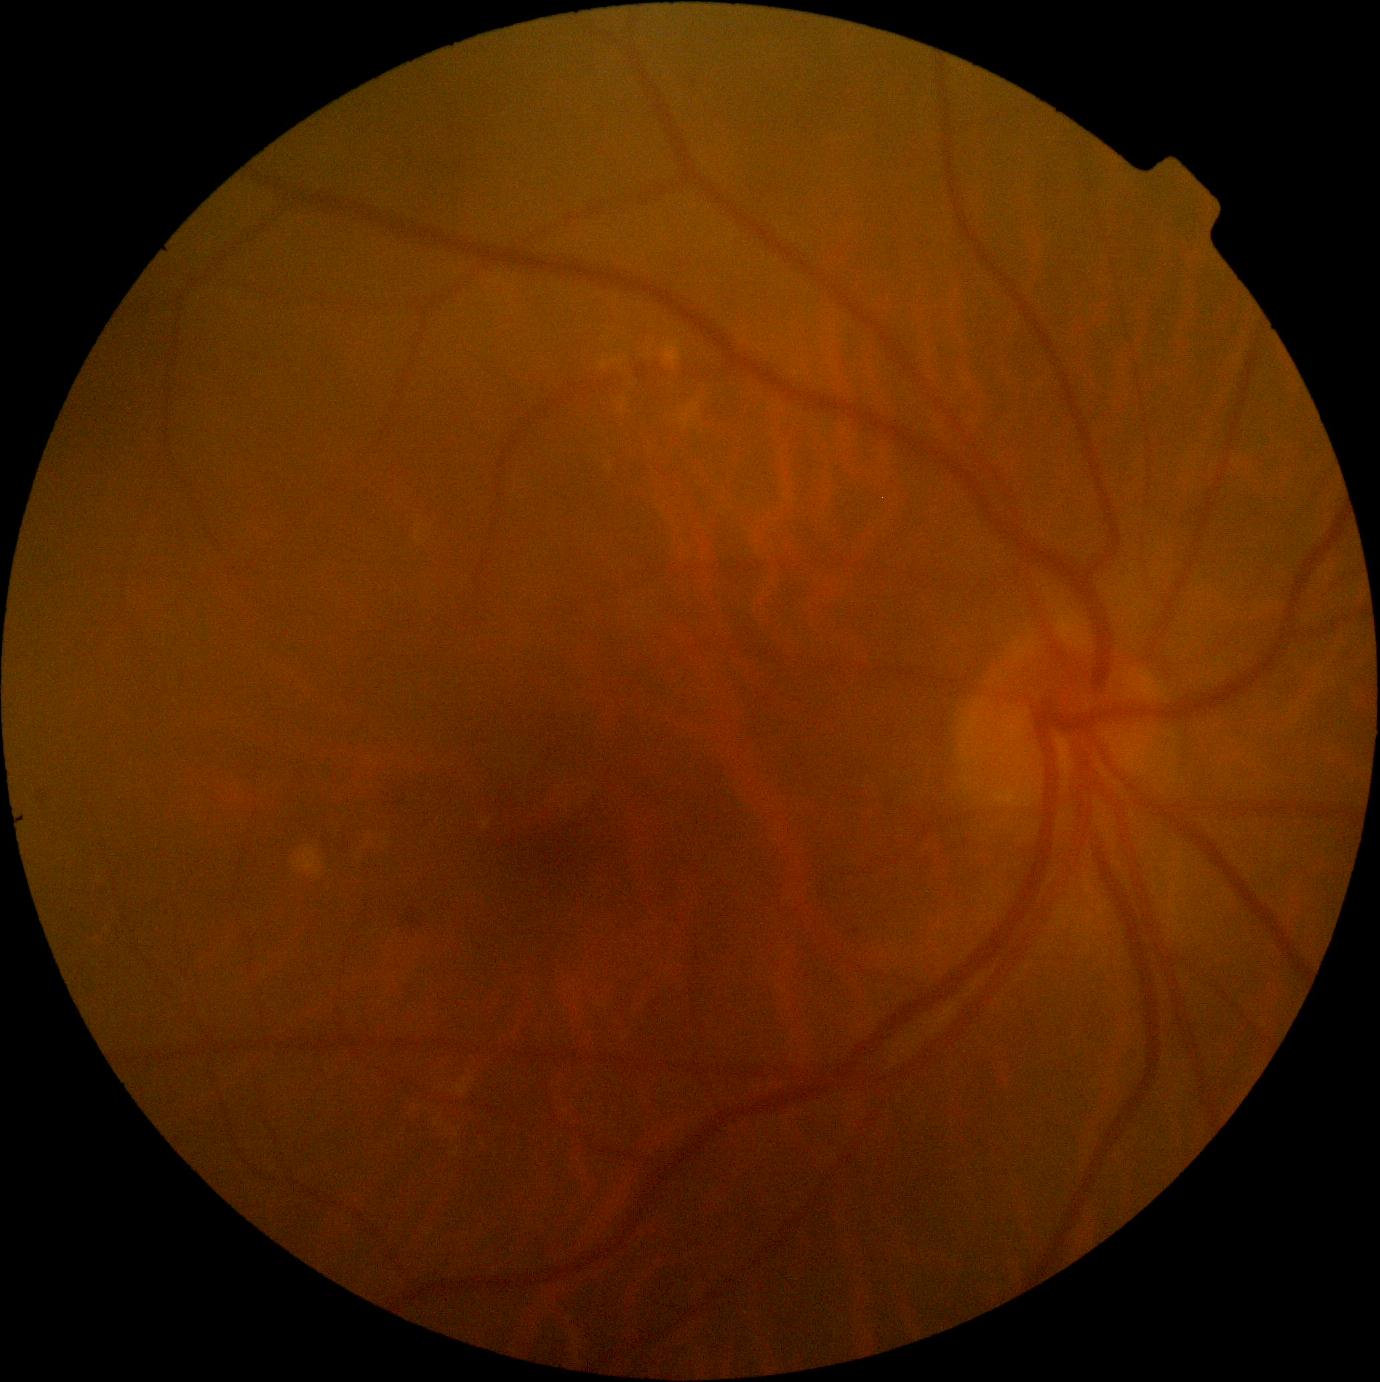

DR class@non-proliferative diabetic retinopathy; DR severity@moderate non-proliferative diabetic retinopathy (grade 2).